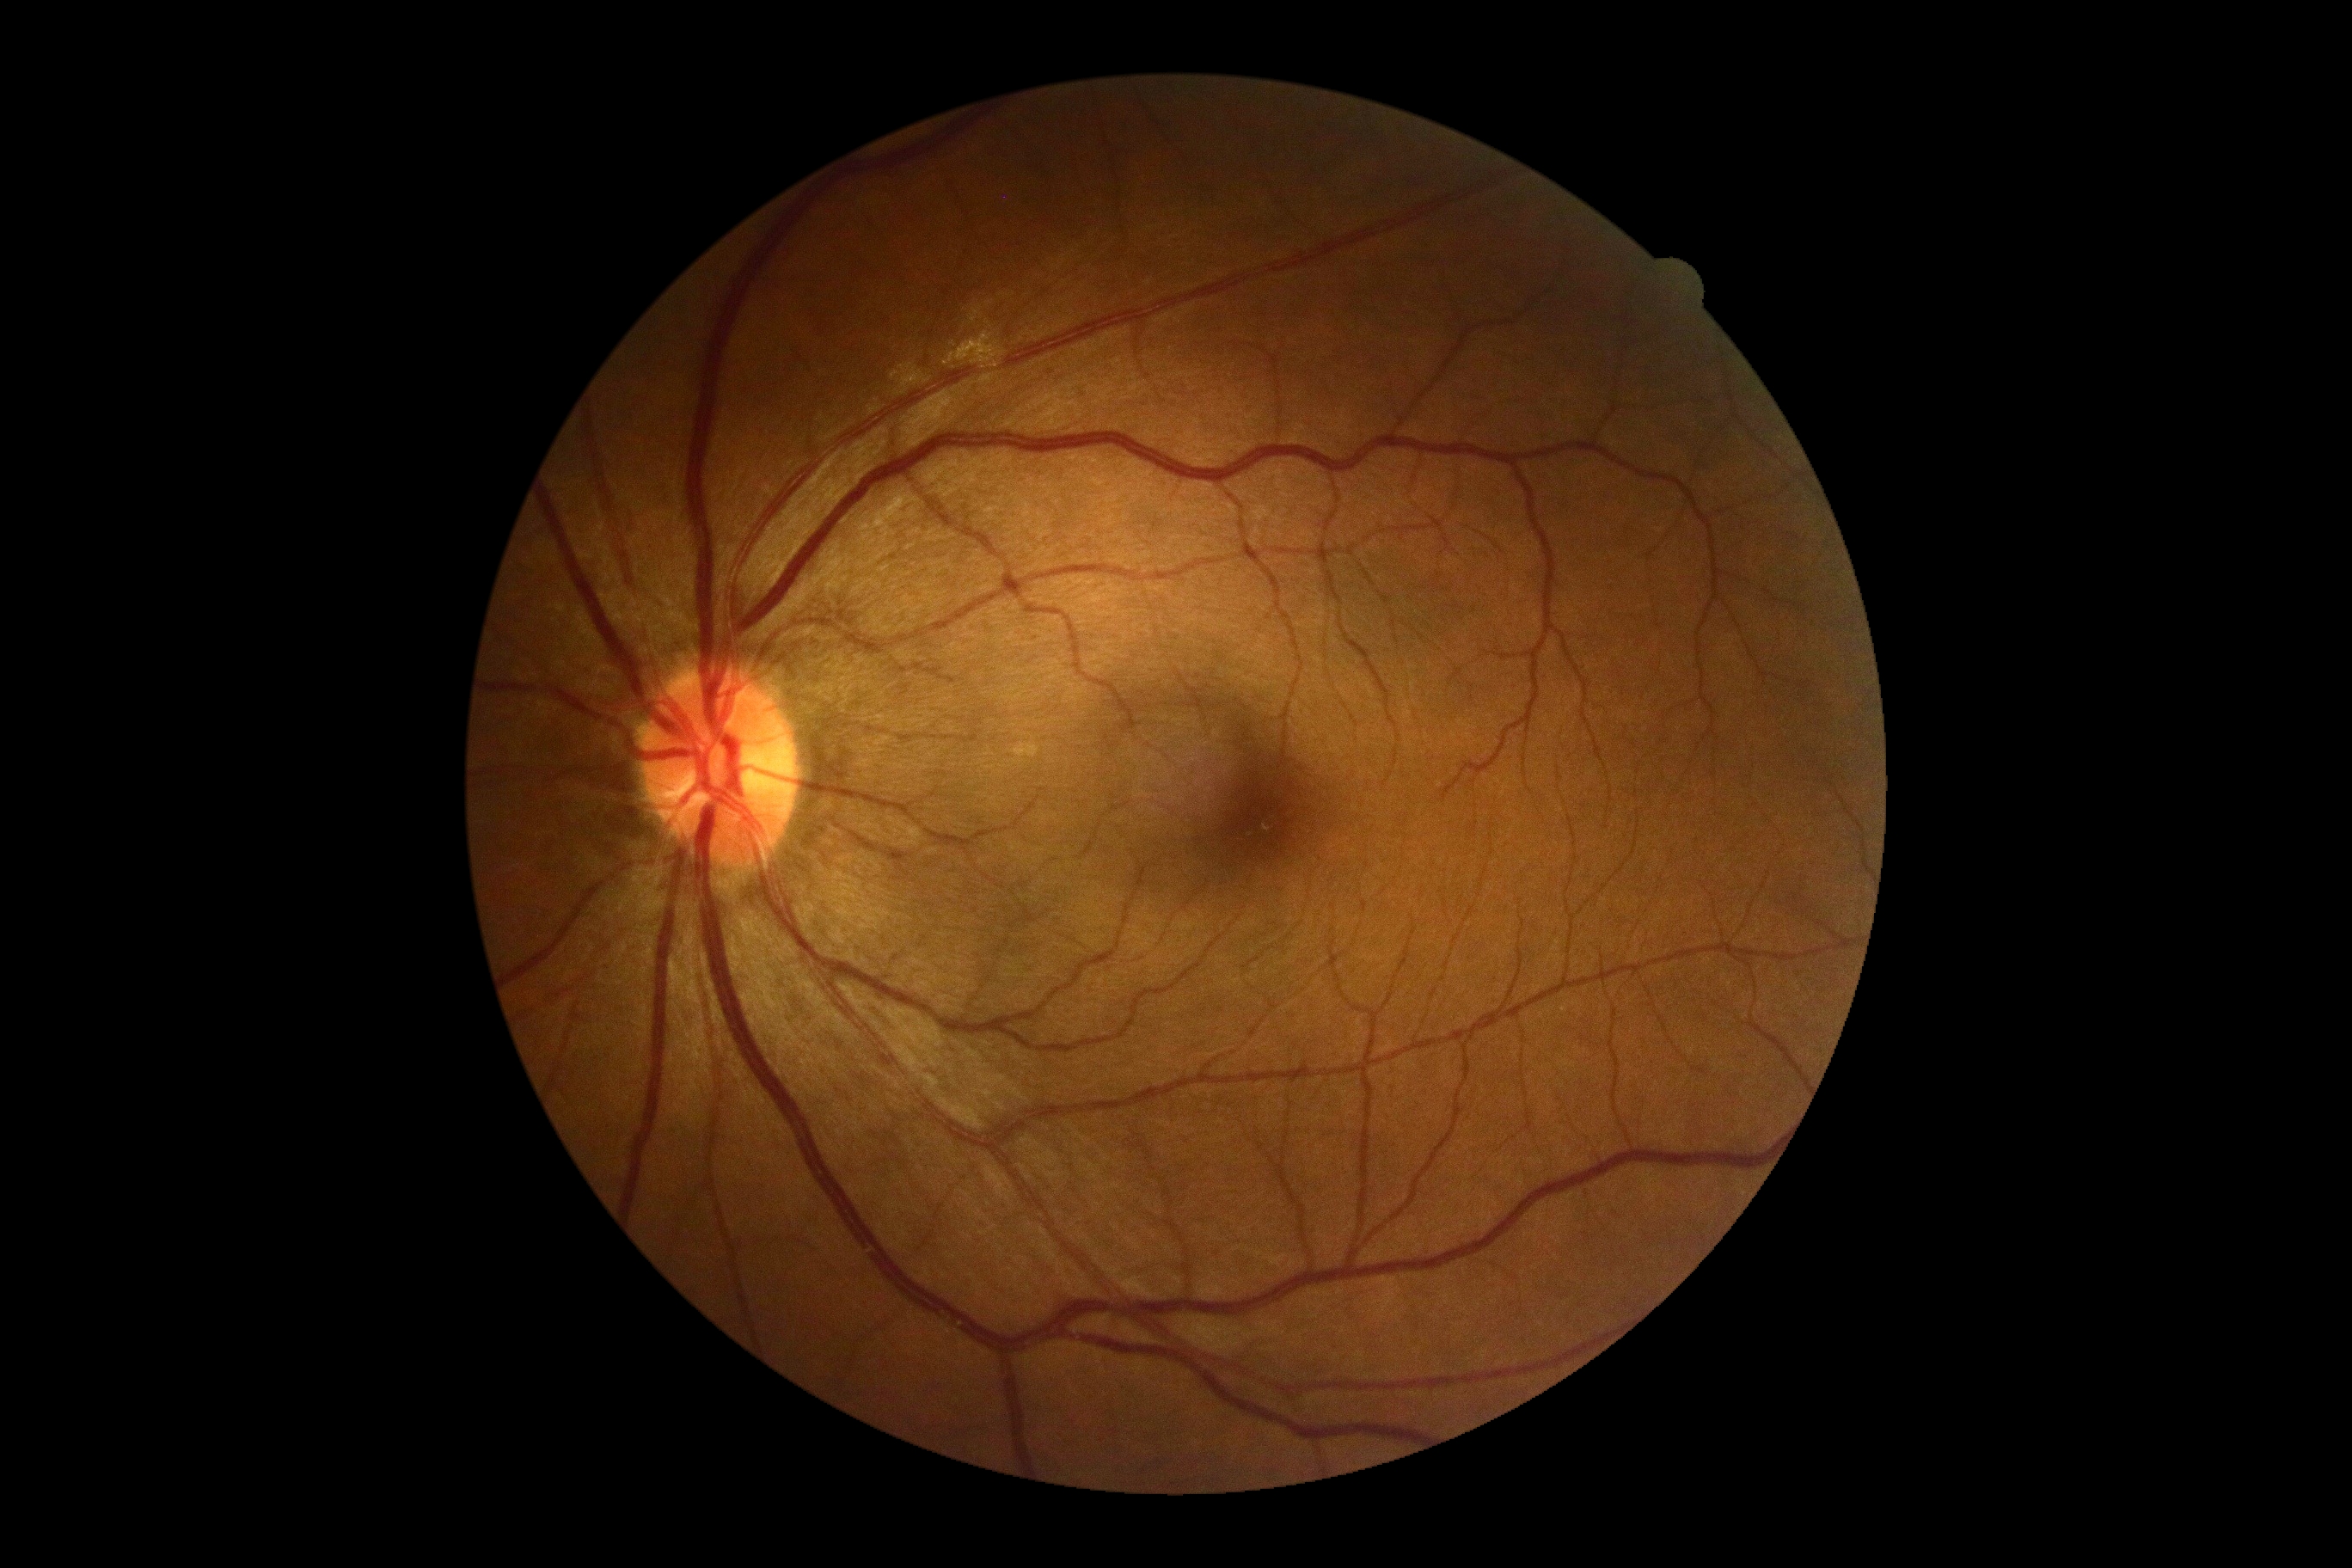

retinopathy = 0